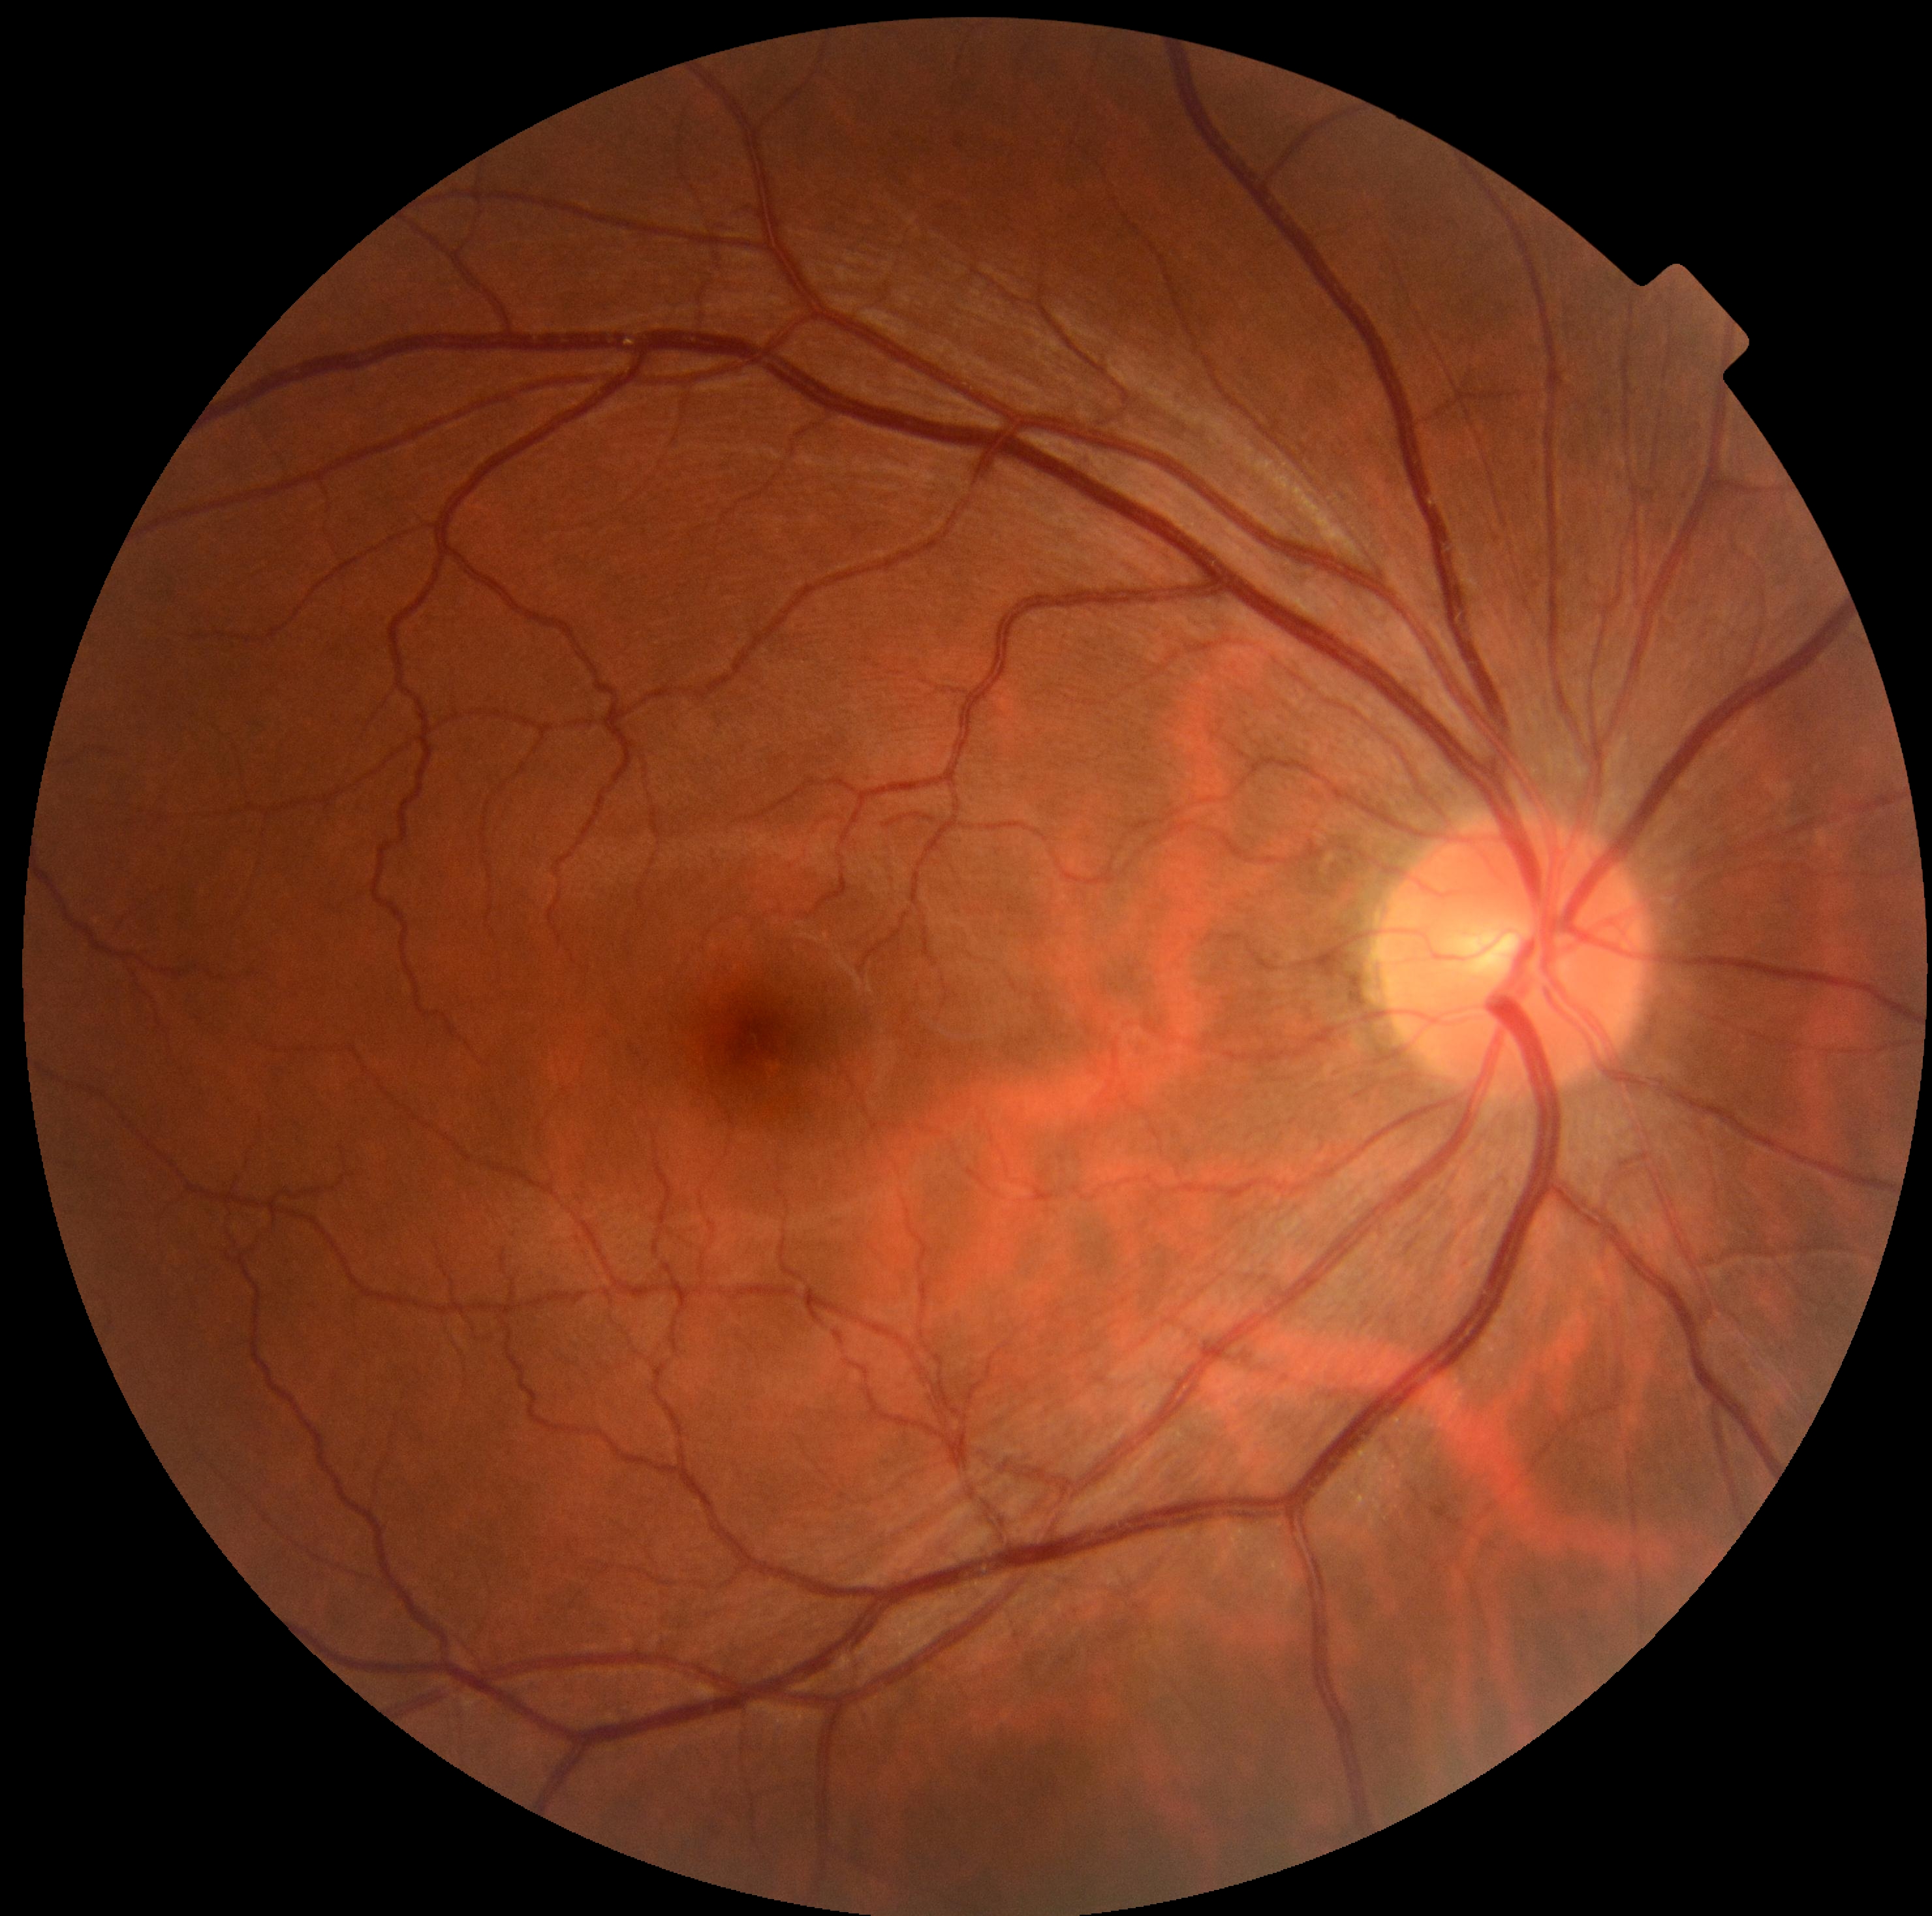

Annotations:
• diabetic retinopathy: 0/4
• DR impression: no DR findings